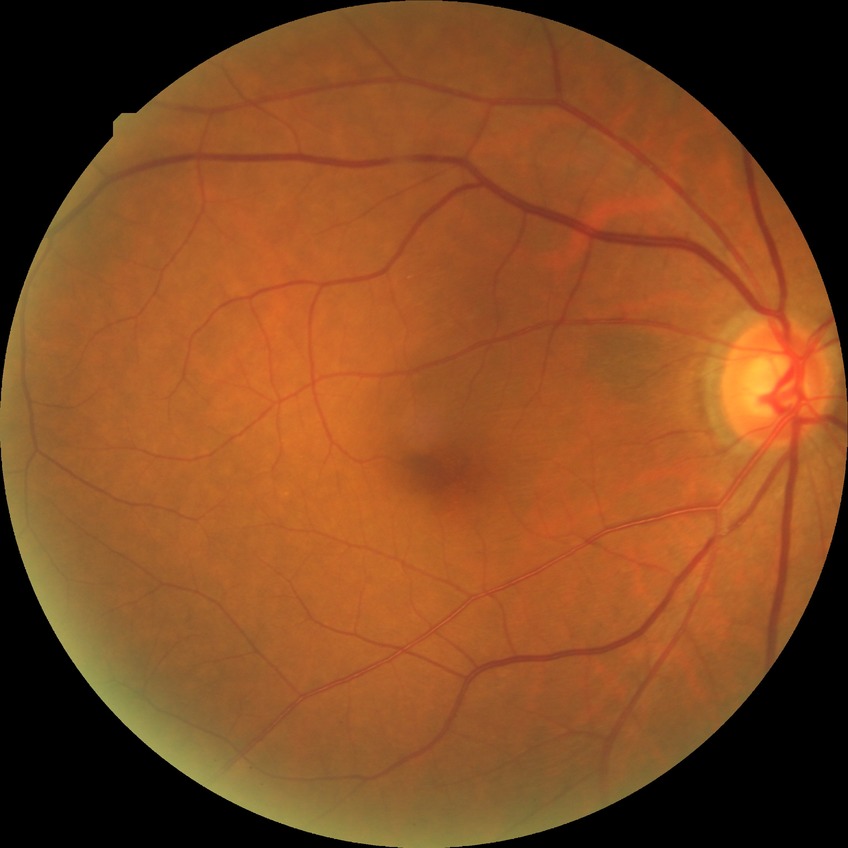
Diabetic retinopathy stage is no diabetic retinopathy.